Camera: Natus RetCam Envision (130° FOV). Wide-field fundus image from infant ROP screening: 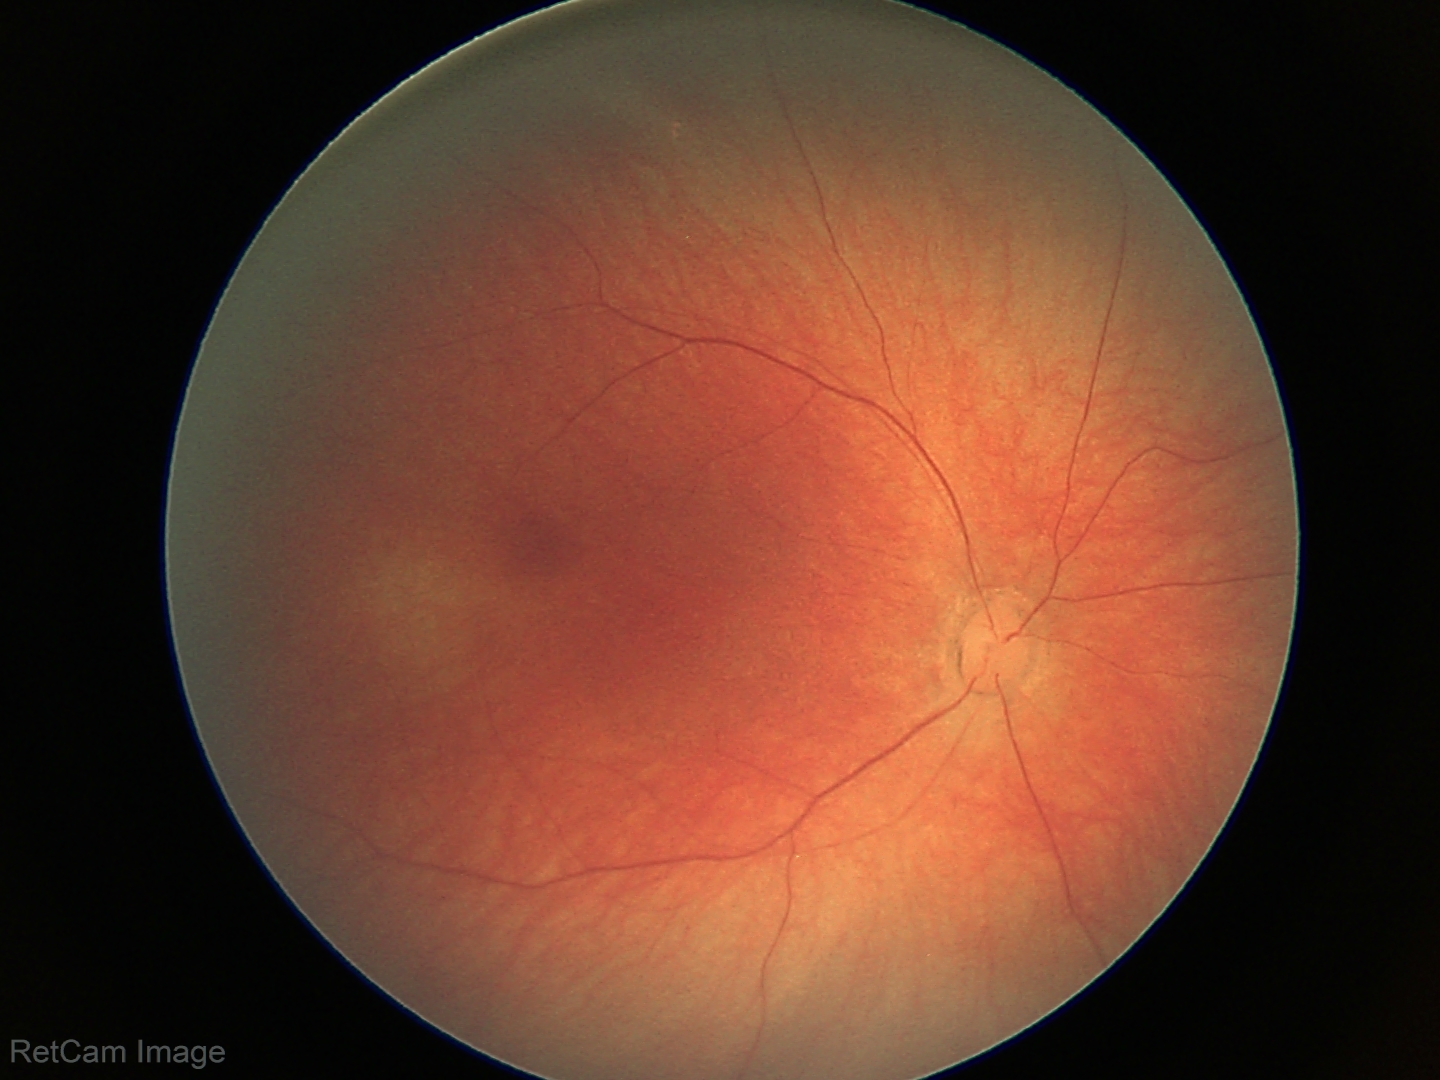 Screening diagnosis: normal fundus examination.